CFP:
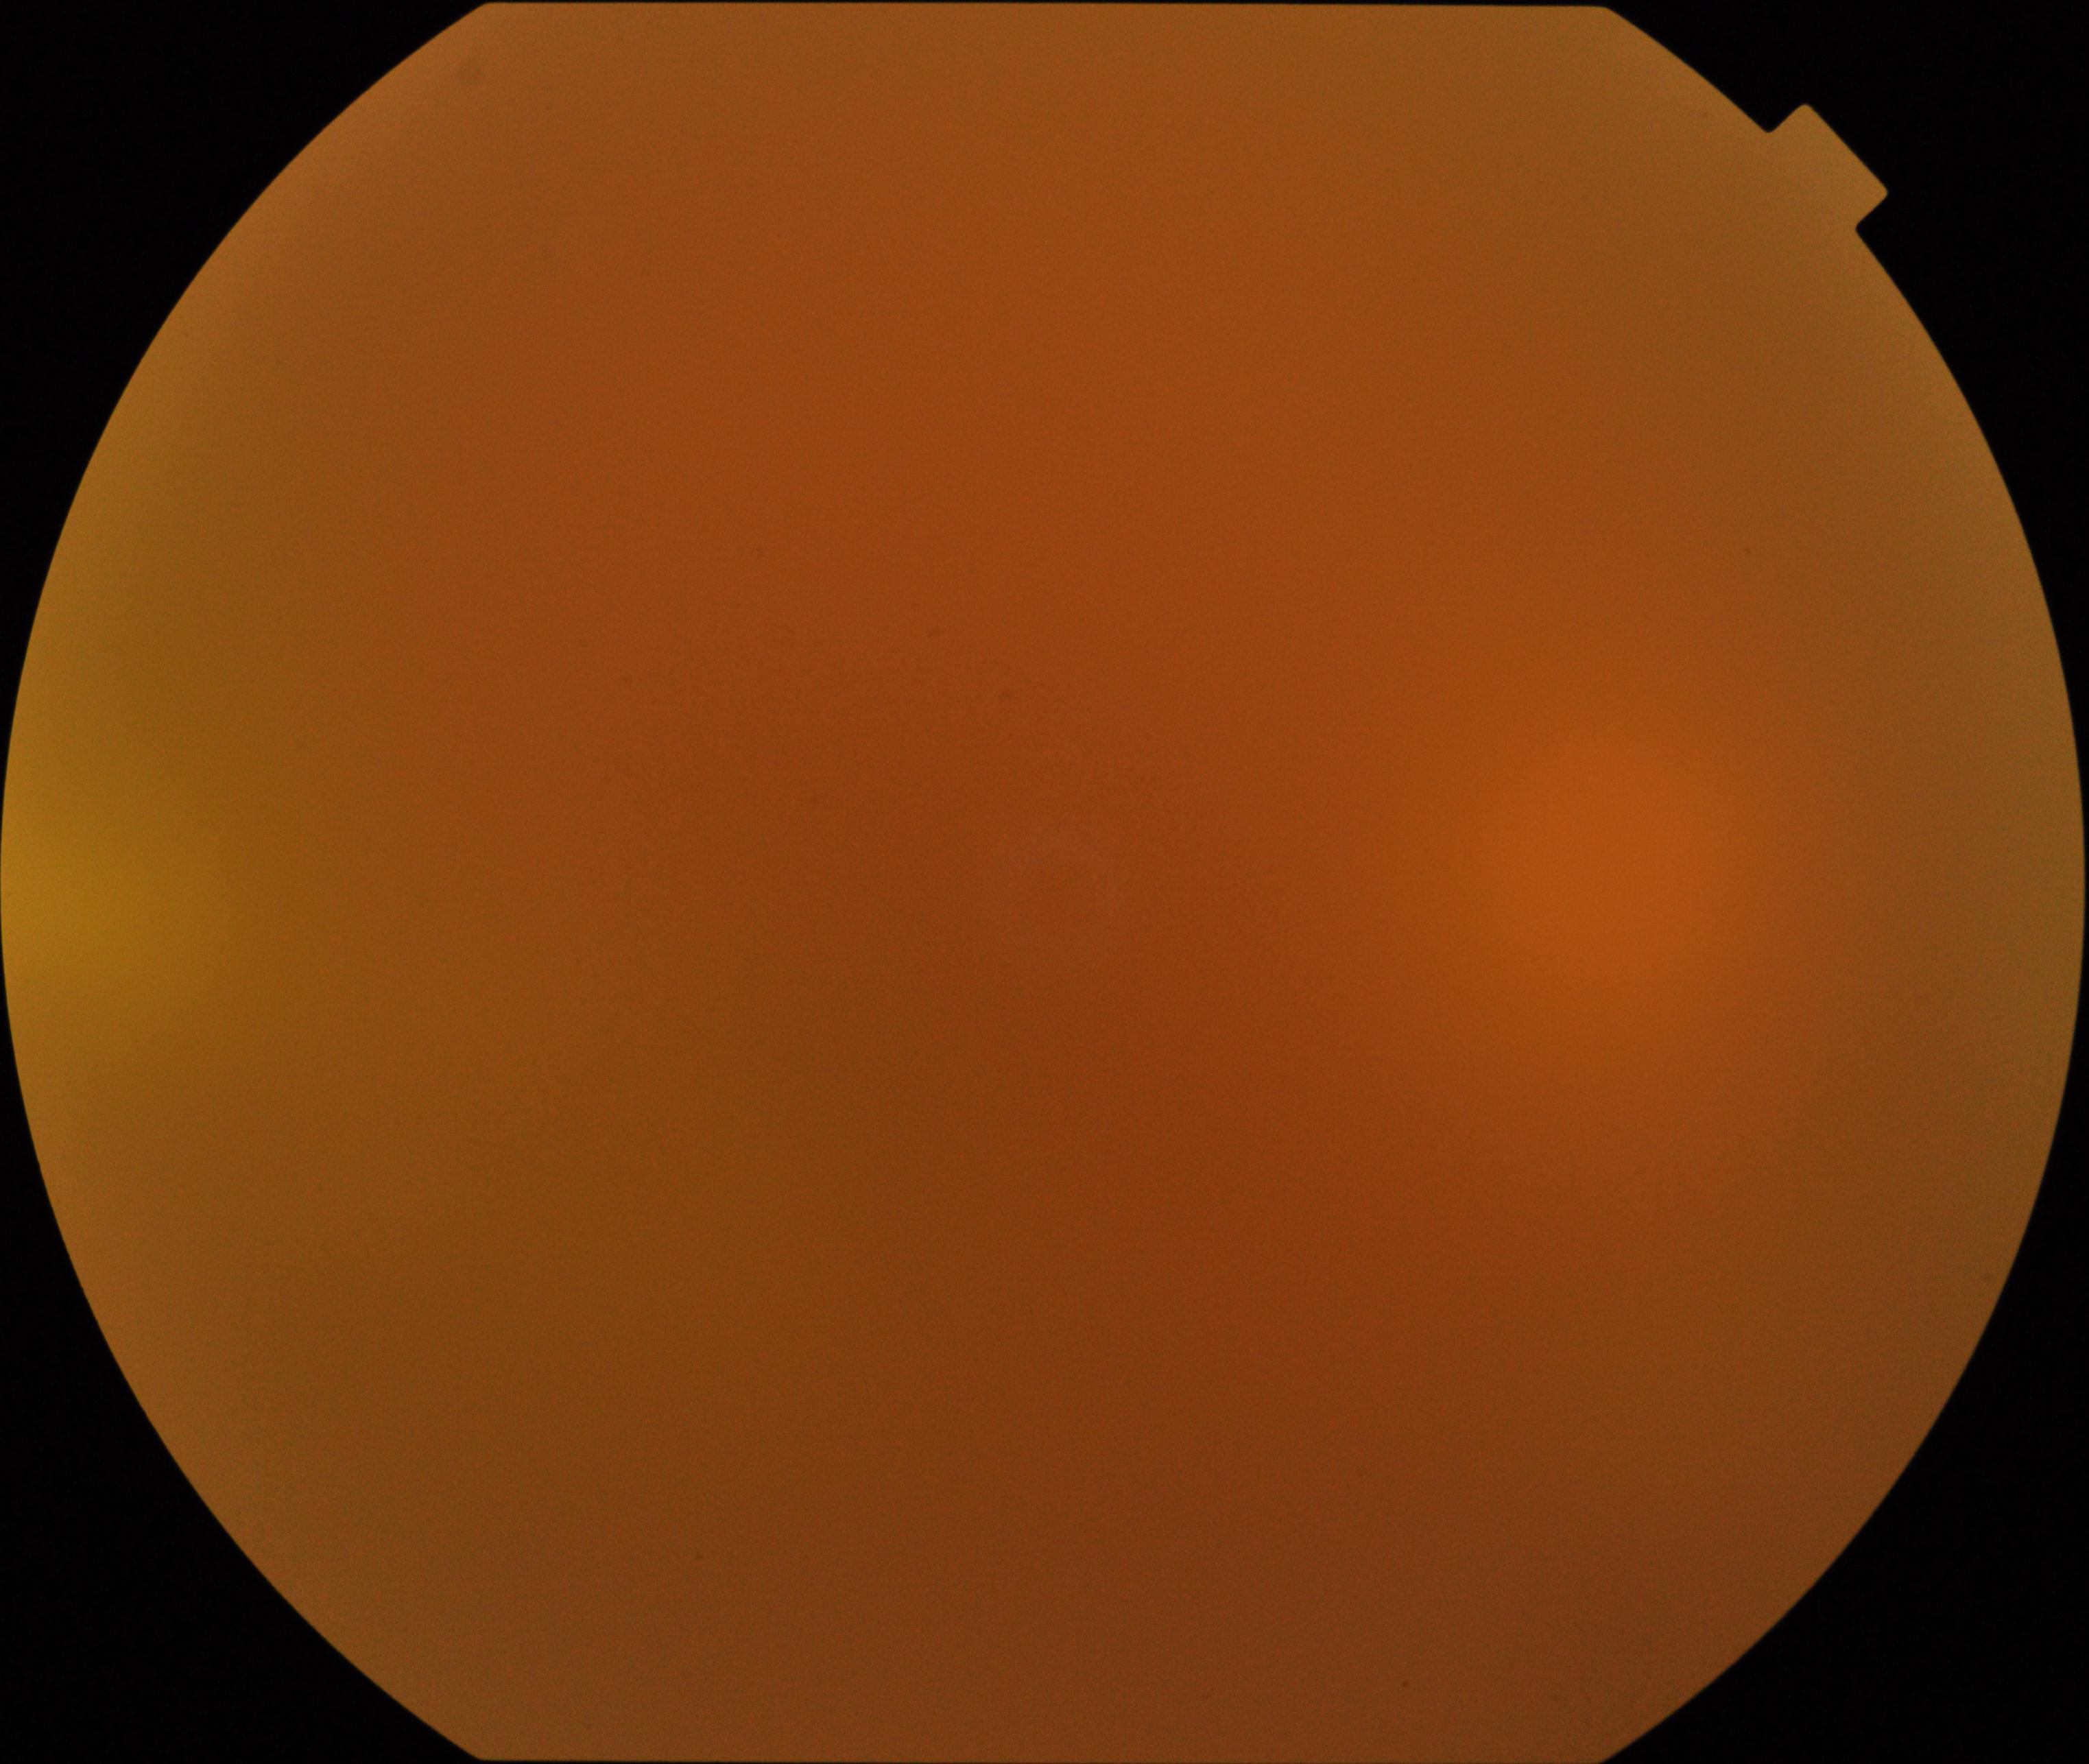 Significantly degraded image quality with obscured retinal detail. Proliferative diabetic retinopathy not identified in the visible portion.